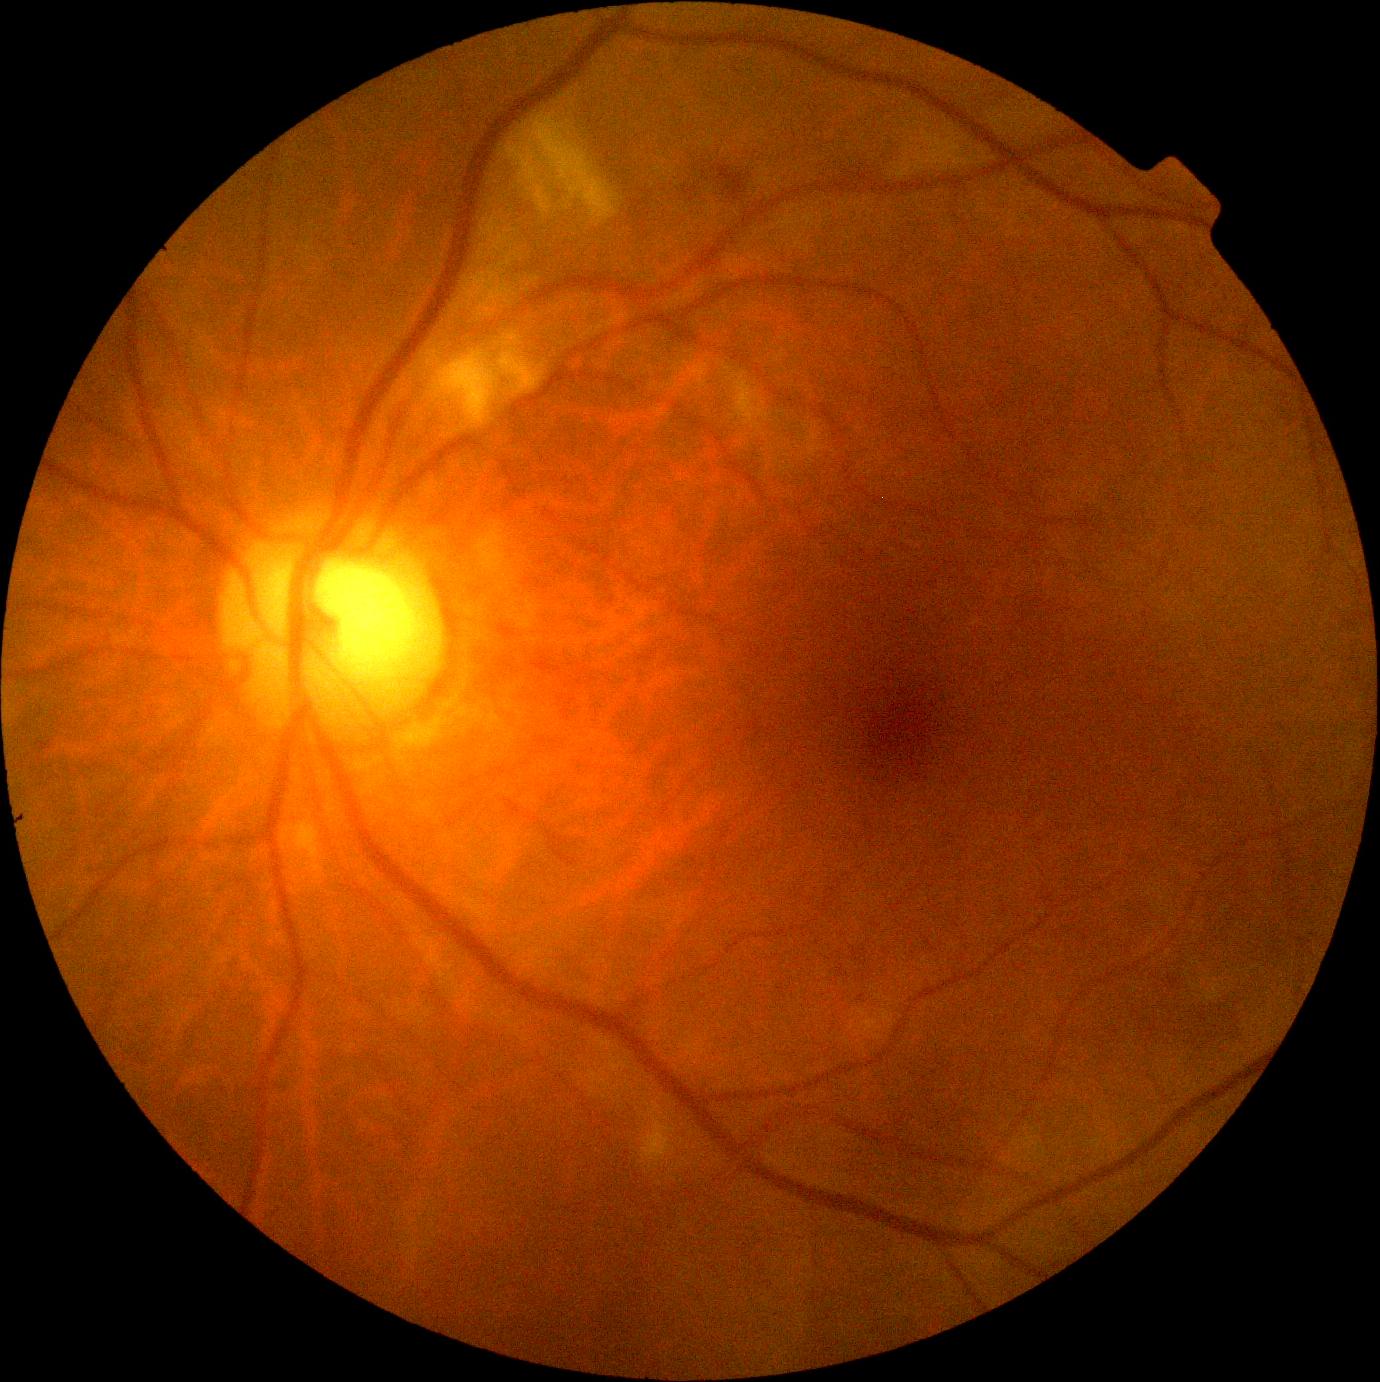

diabetic retinopathy grade: 2 (moderate NPDR).